Handheld portable fundus camera image, 60° FOV, 2212x1659 — 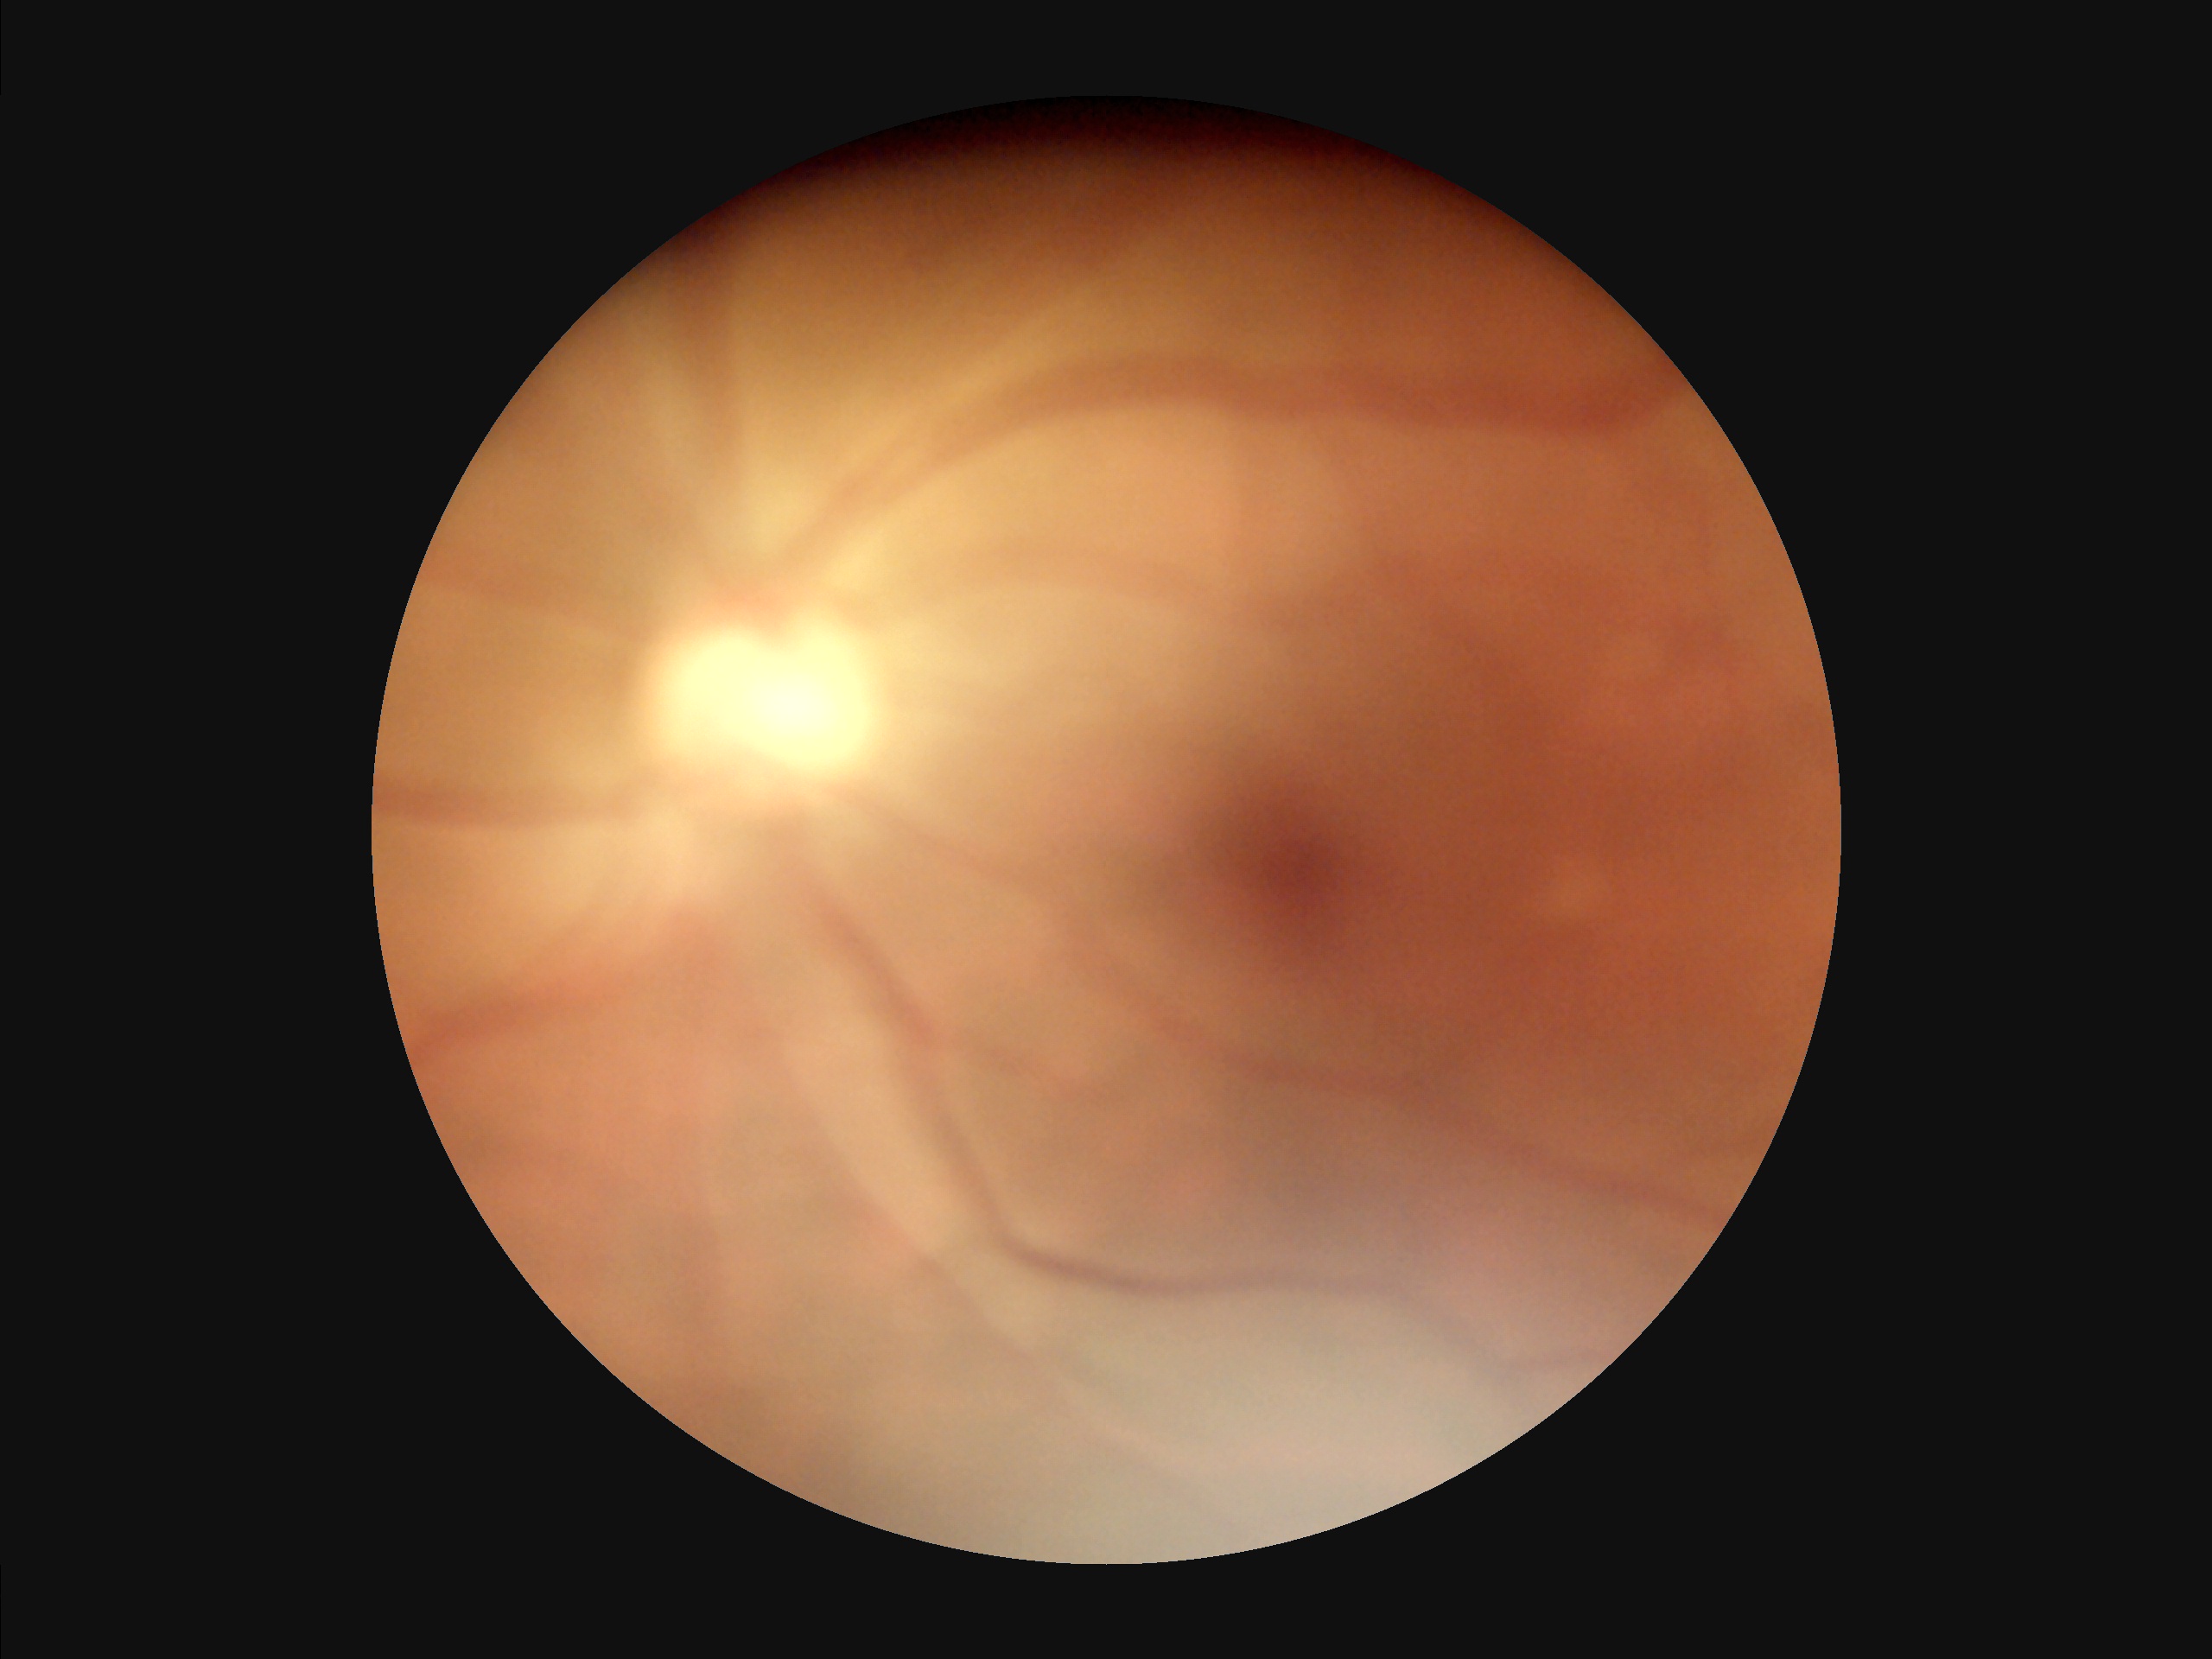
Reduced sharpness with visible blur.
Vessels and details are hard to distinguish.
Overall image quality is poor.